Wide-field fundus photograph from neonatal ROP screening — 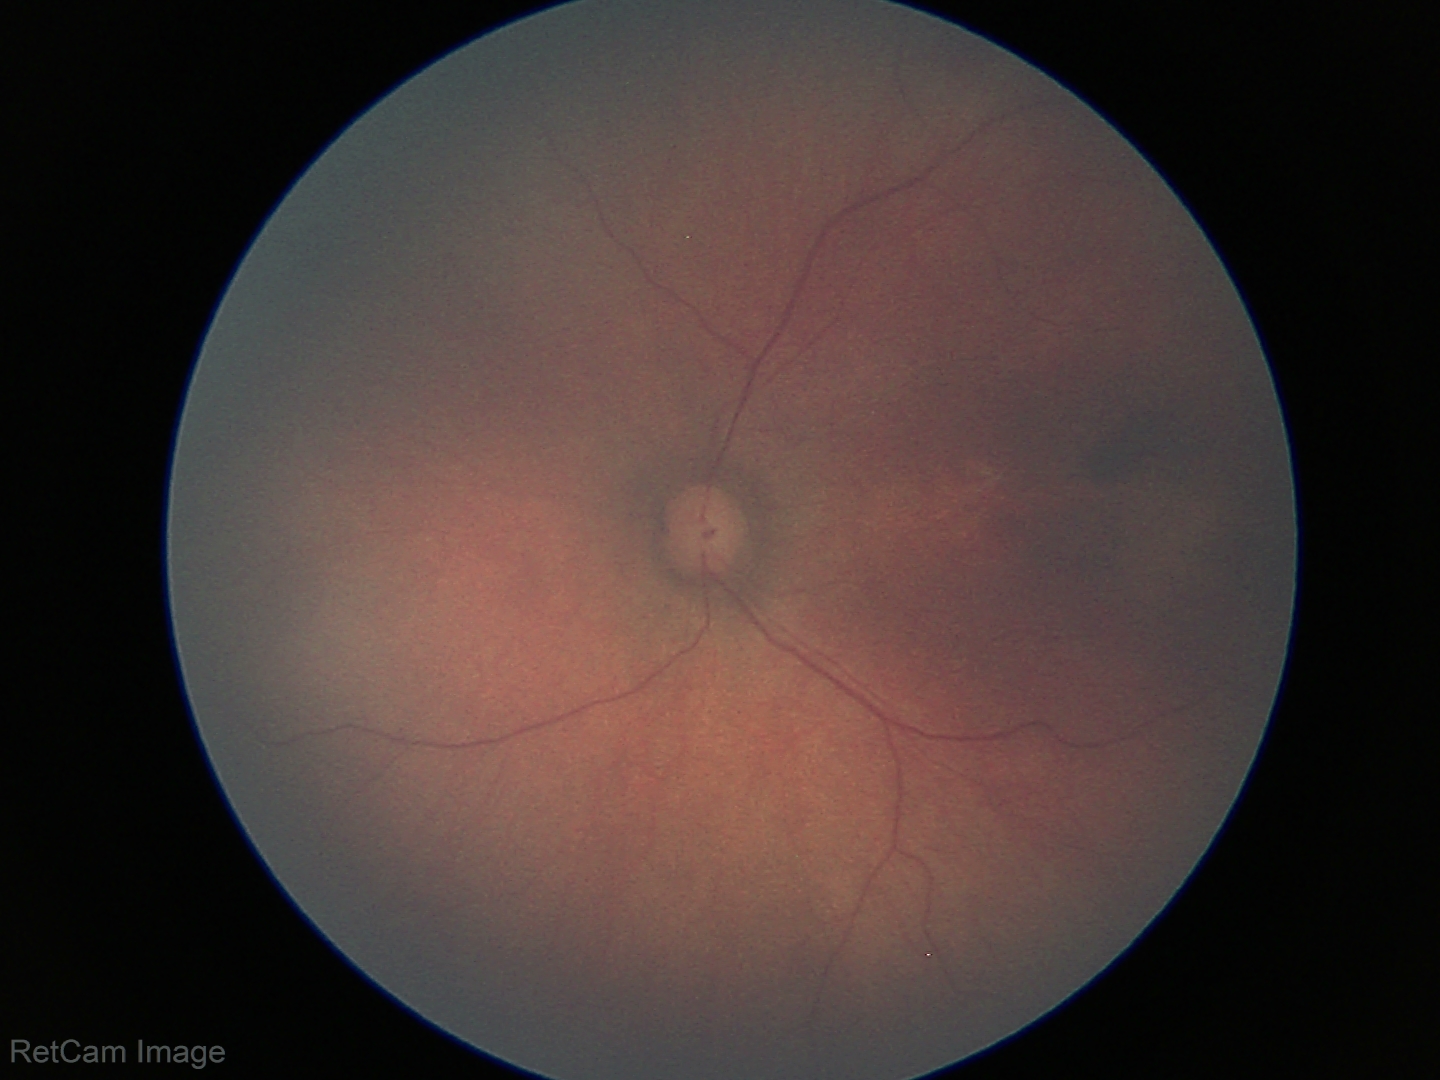
Q: What is the screening diagnosis?
A: no abnormal retinal findings